Nonmydriatic.
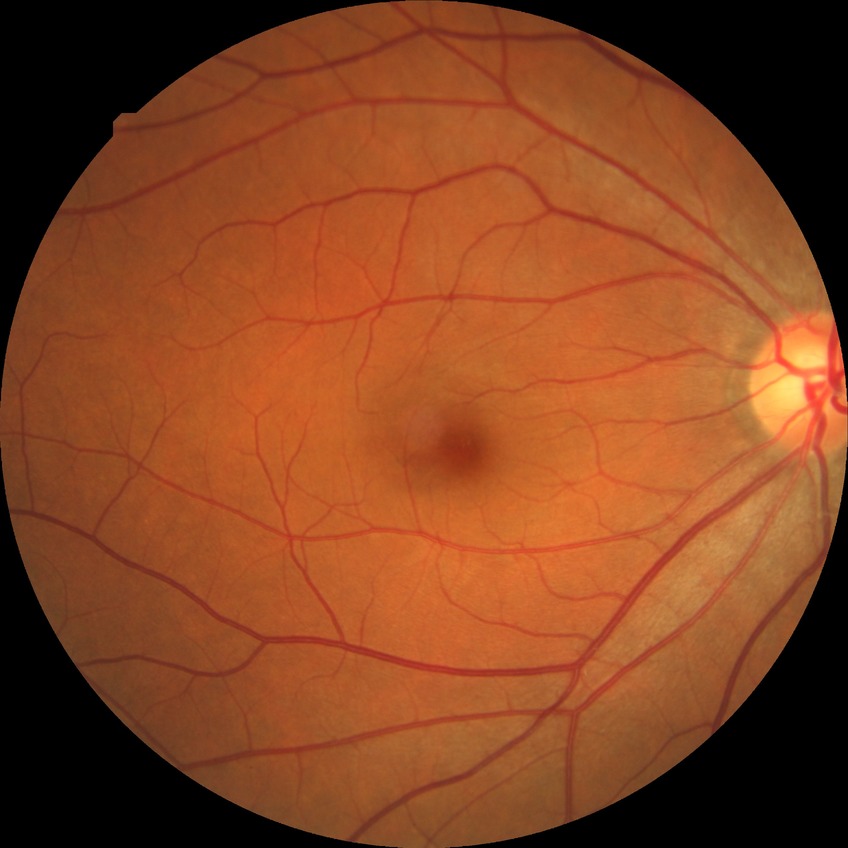 DR severity is NDR. No diabetic retinal disease findings.